2212x1659px. 45° field of view. Retinal fundus photograph.
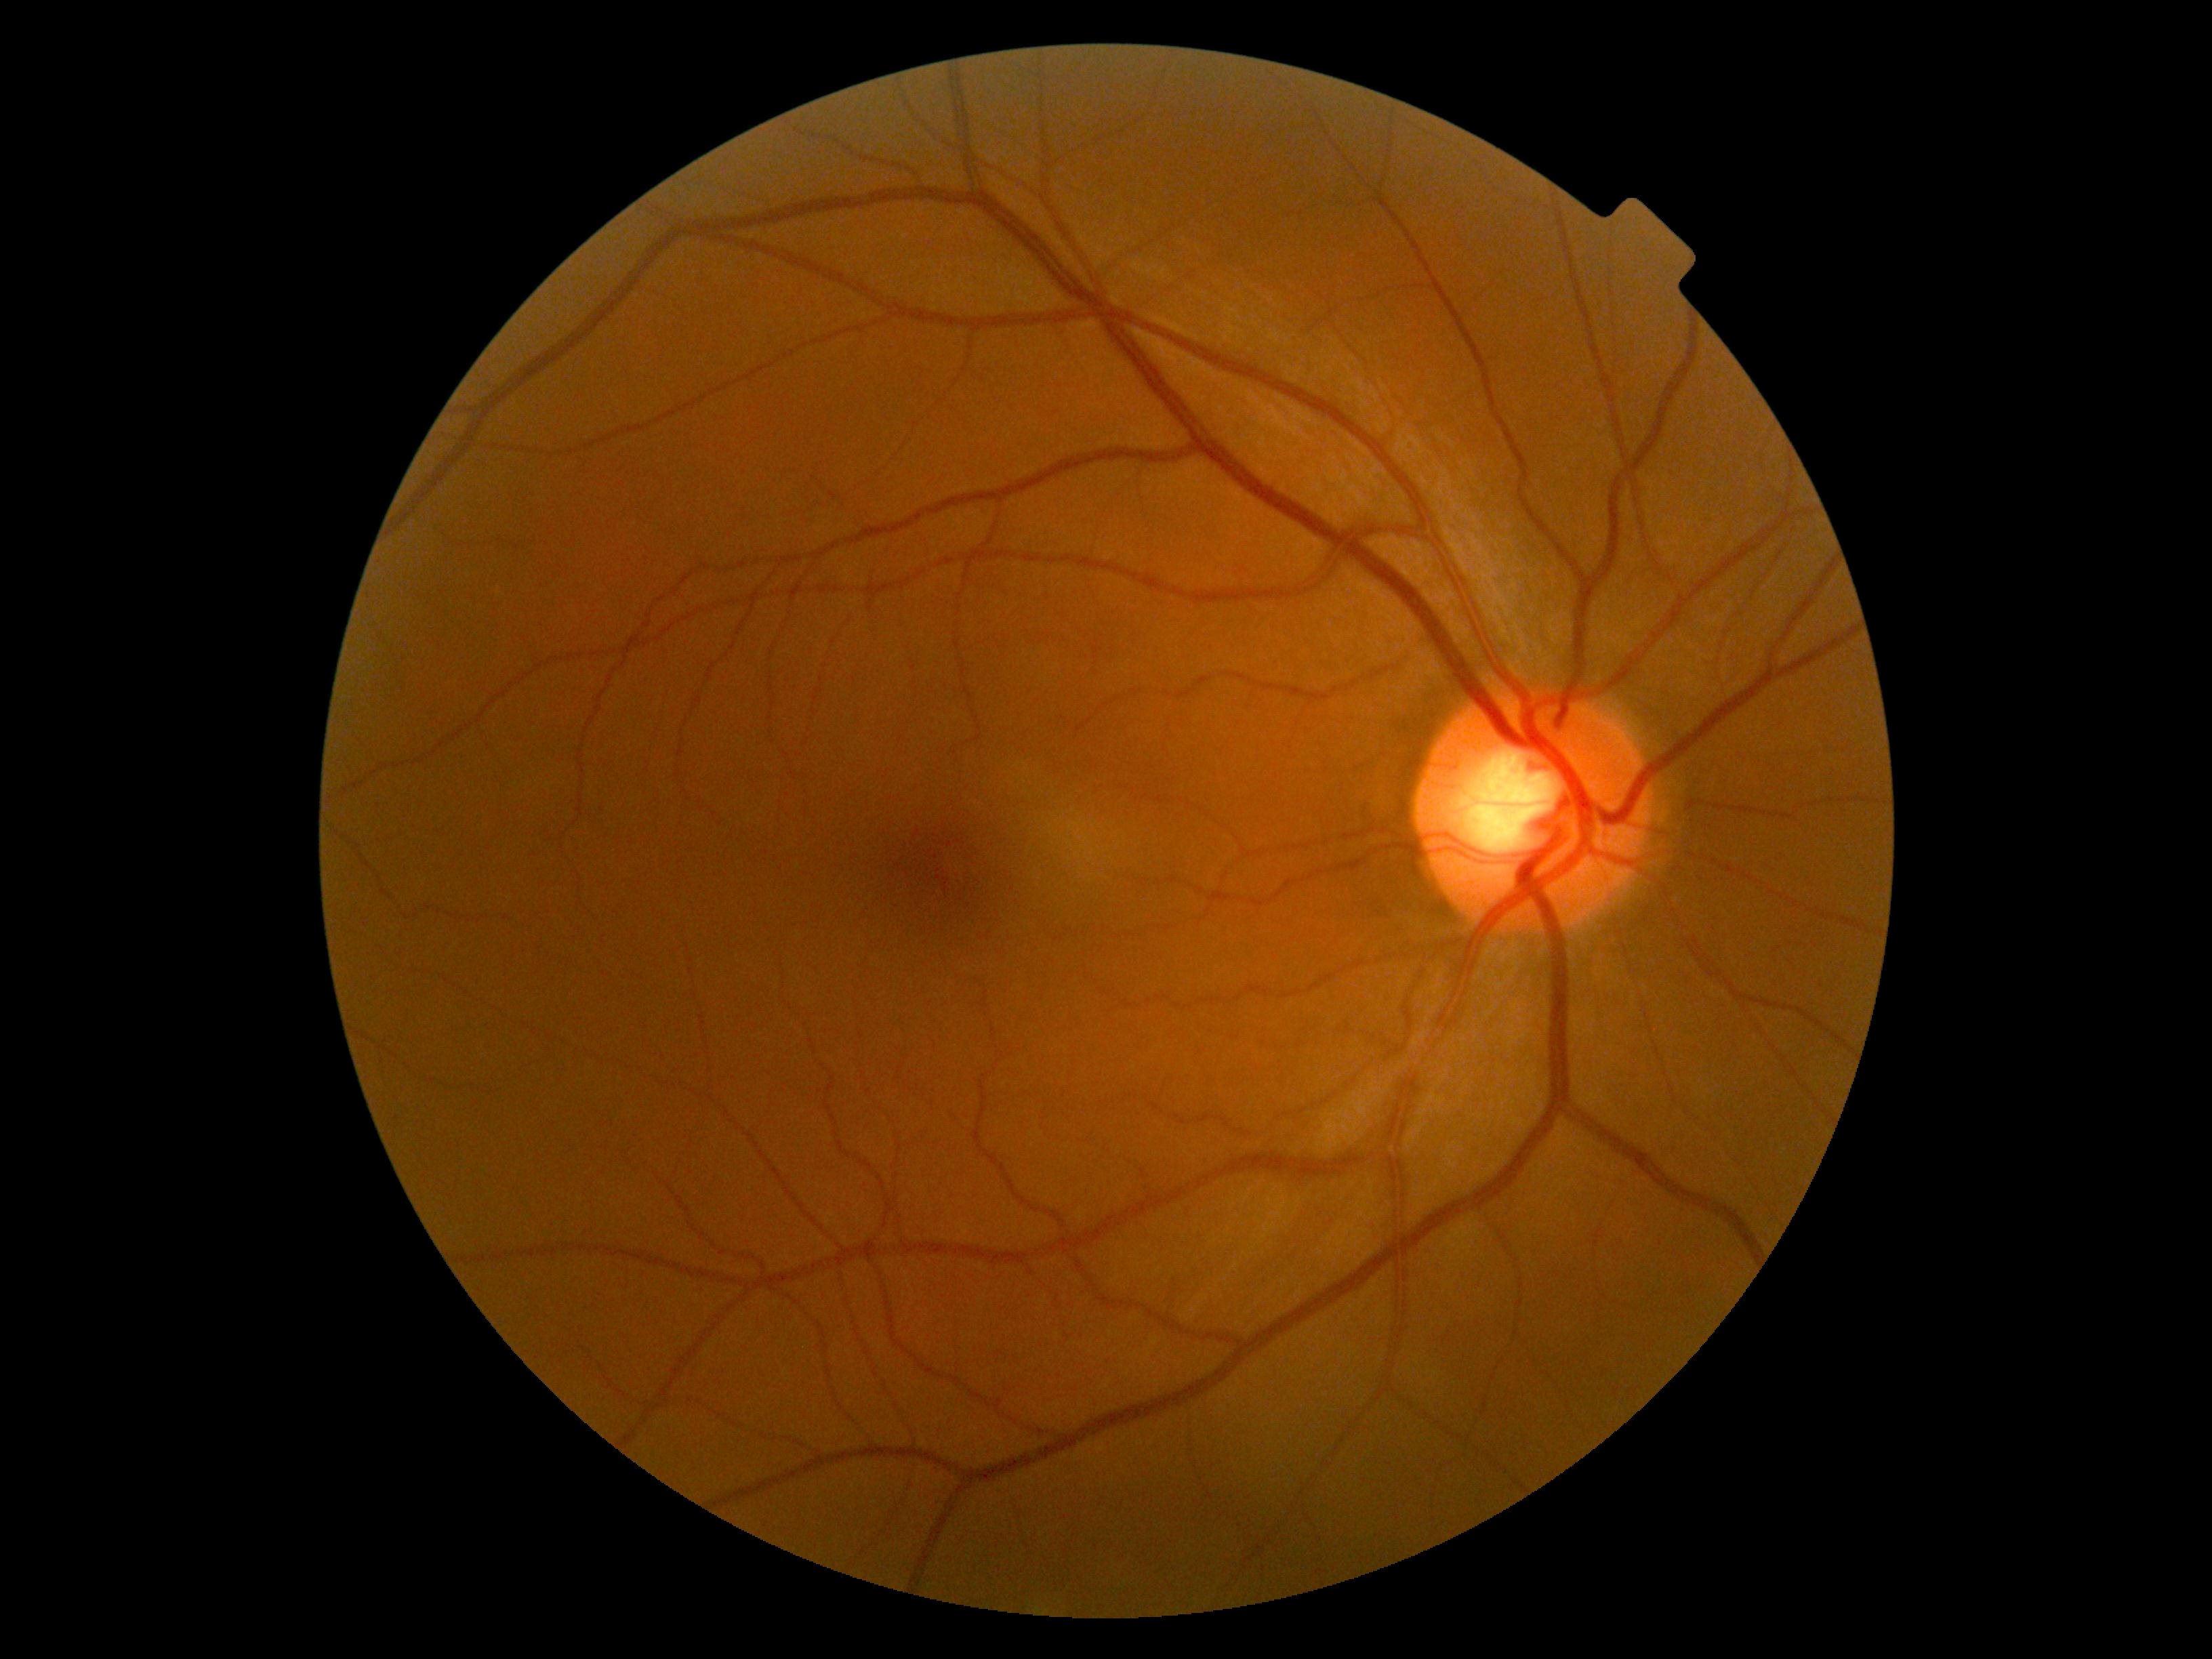 - DR stage: 0 — no visible signs of diabetic retinopathy